Camera: NIDEK AFC-230, 45° field of view, CFP, 848 x 848 pixels: 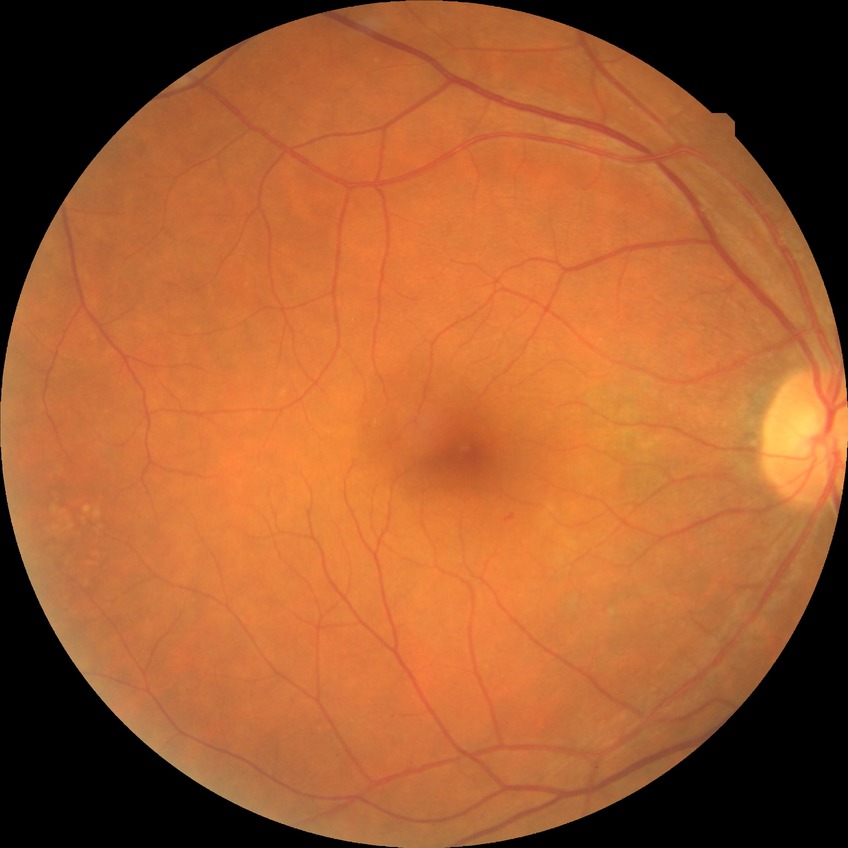
diabetic retinopathy (DR) = no diabetic retinopathy (NDR).